Dilated pupil, optic disc-centered crop from a color fundus photograph, 35° FOV before cropping — 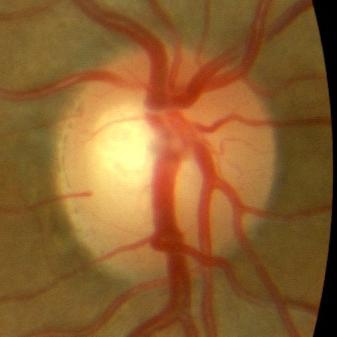
Showing no glaucomatous damage.